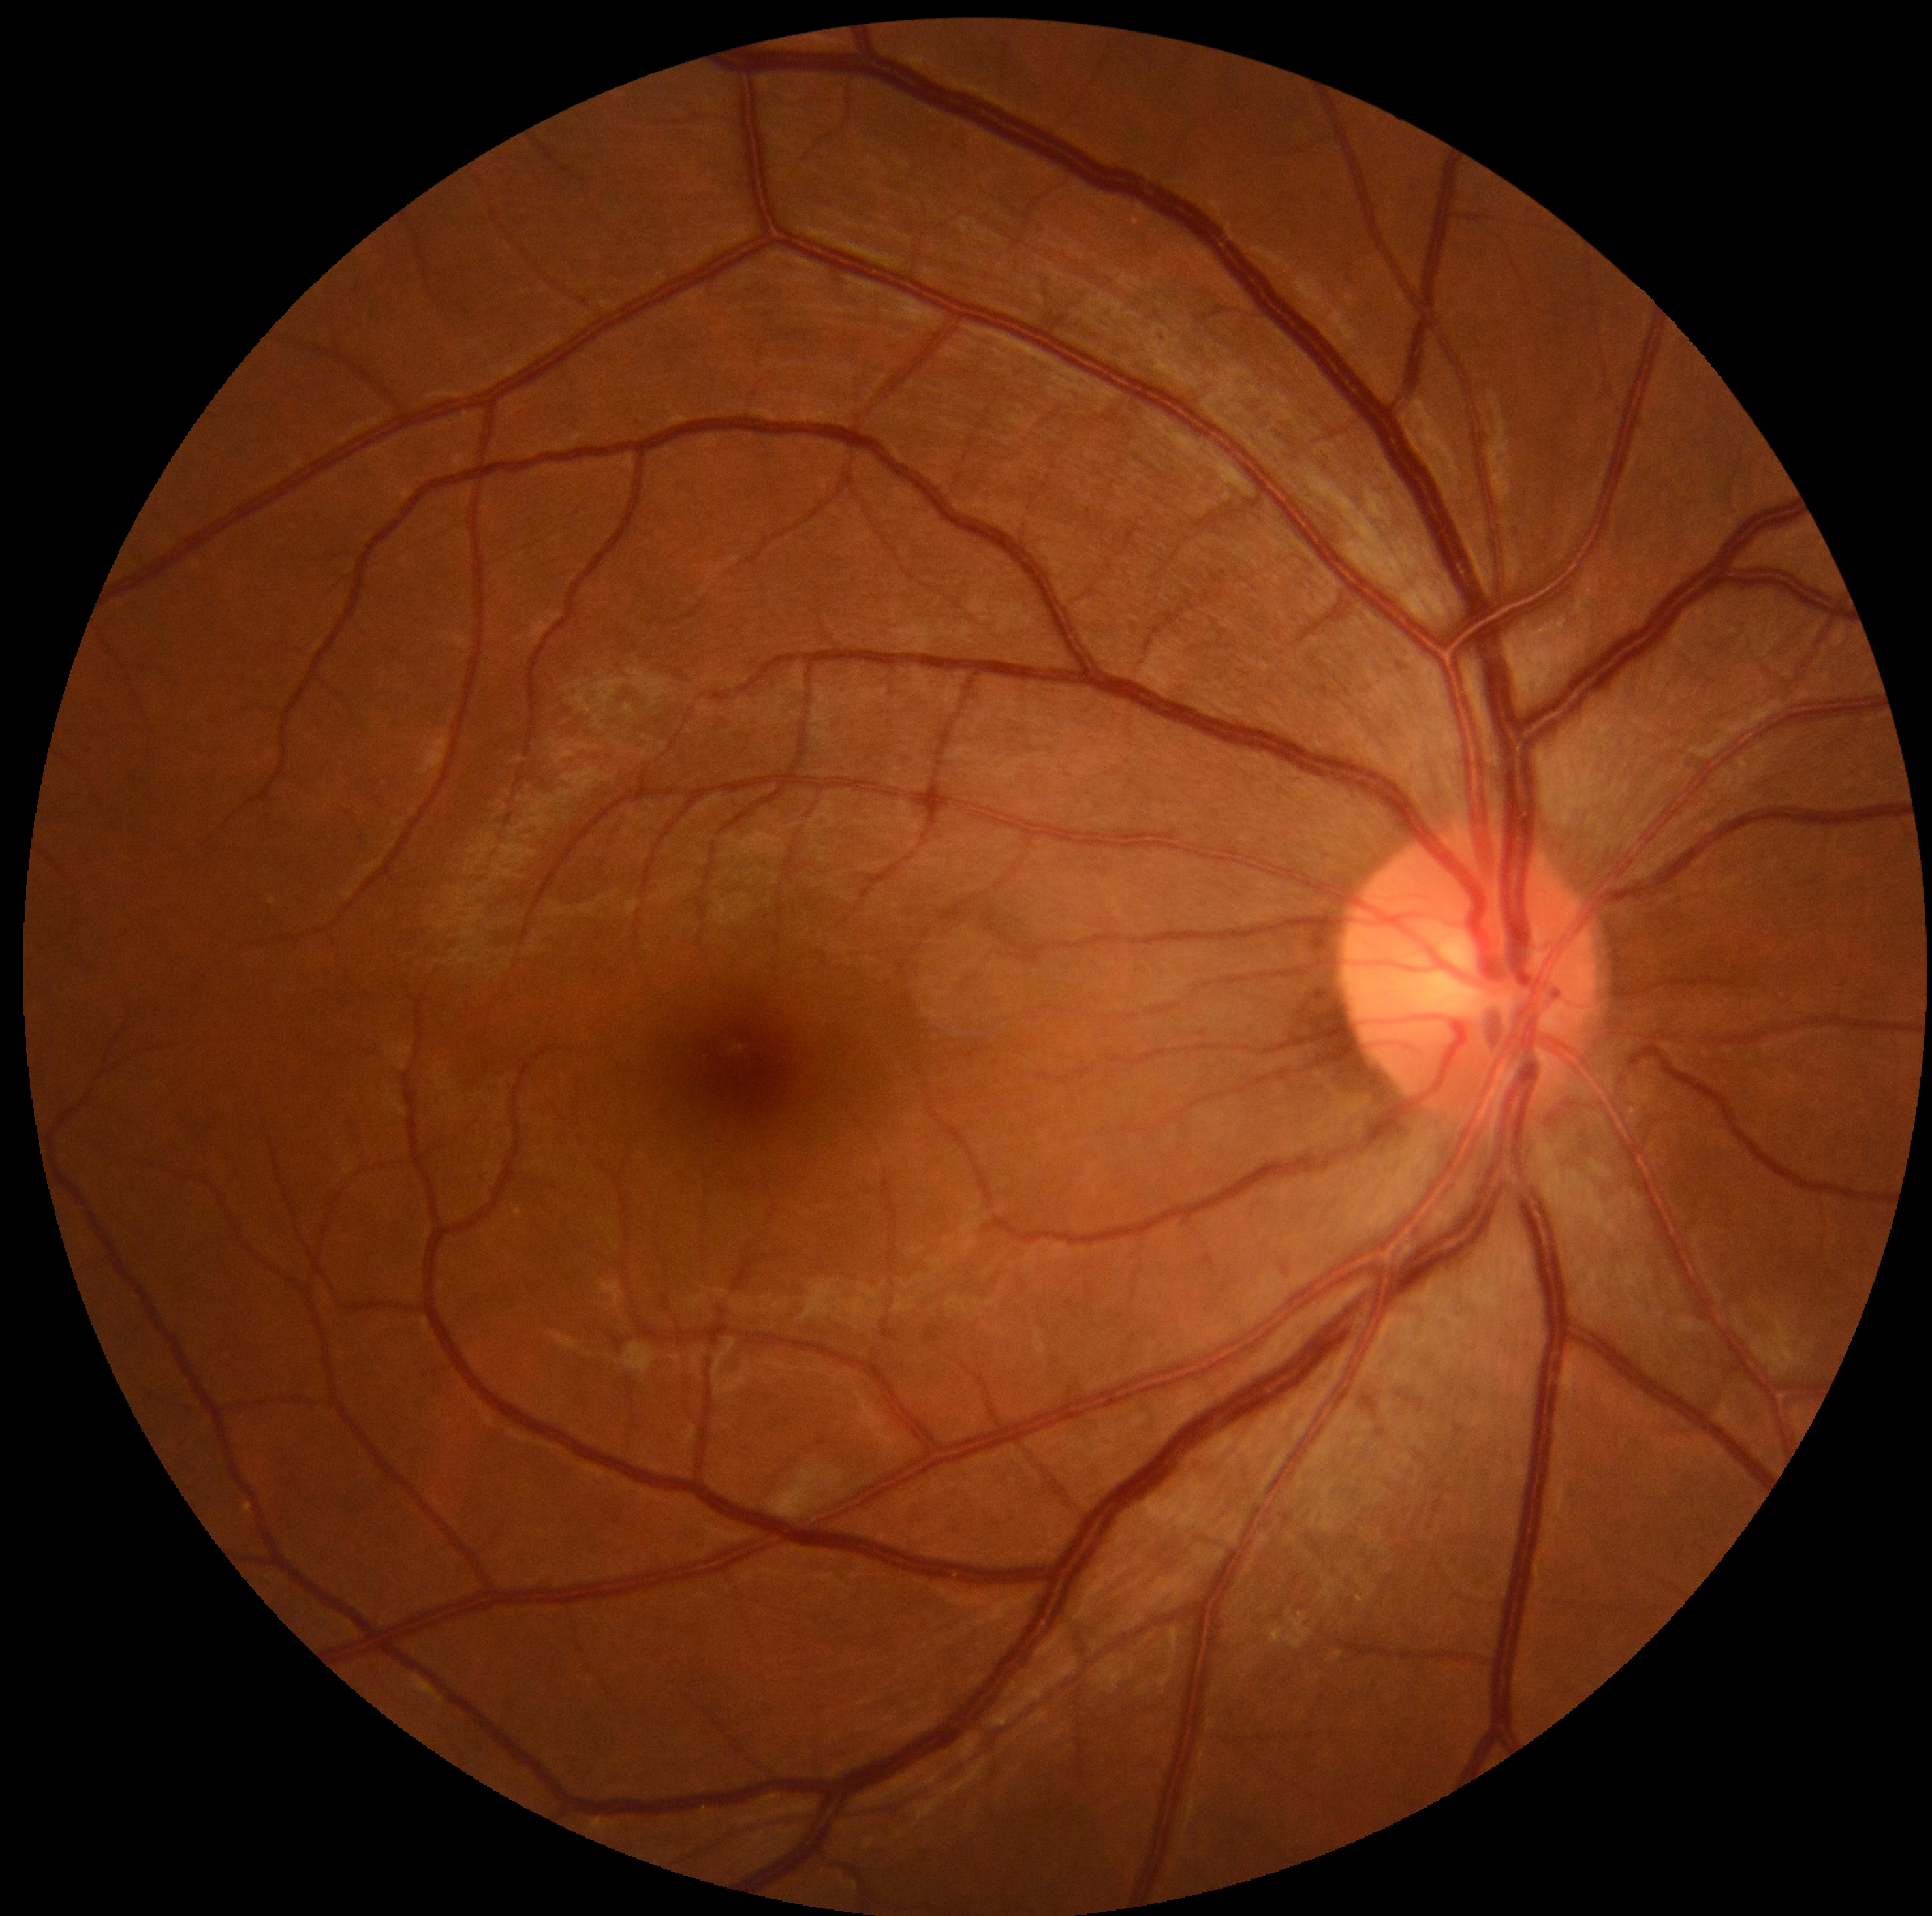 No apparent diabetic retinopathy. Diabetic retinopathy (DR): 0/4.